200-degree field of view — 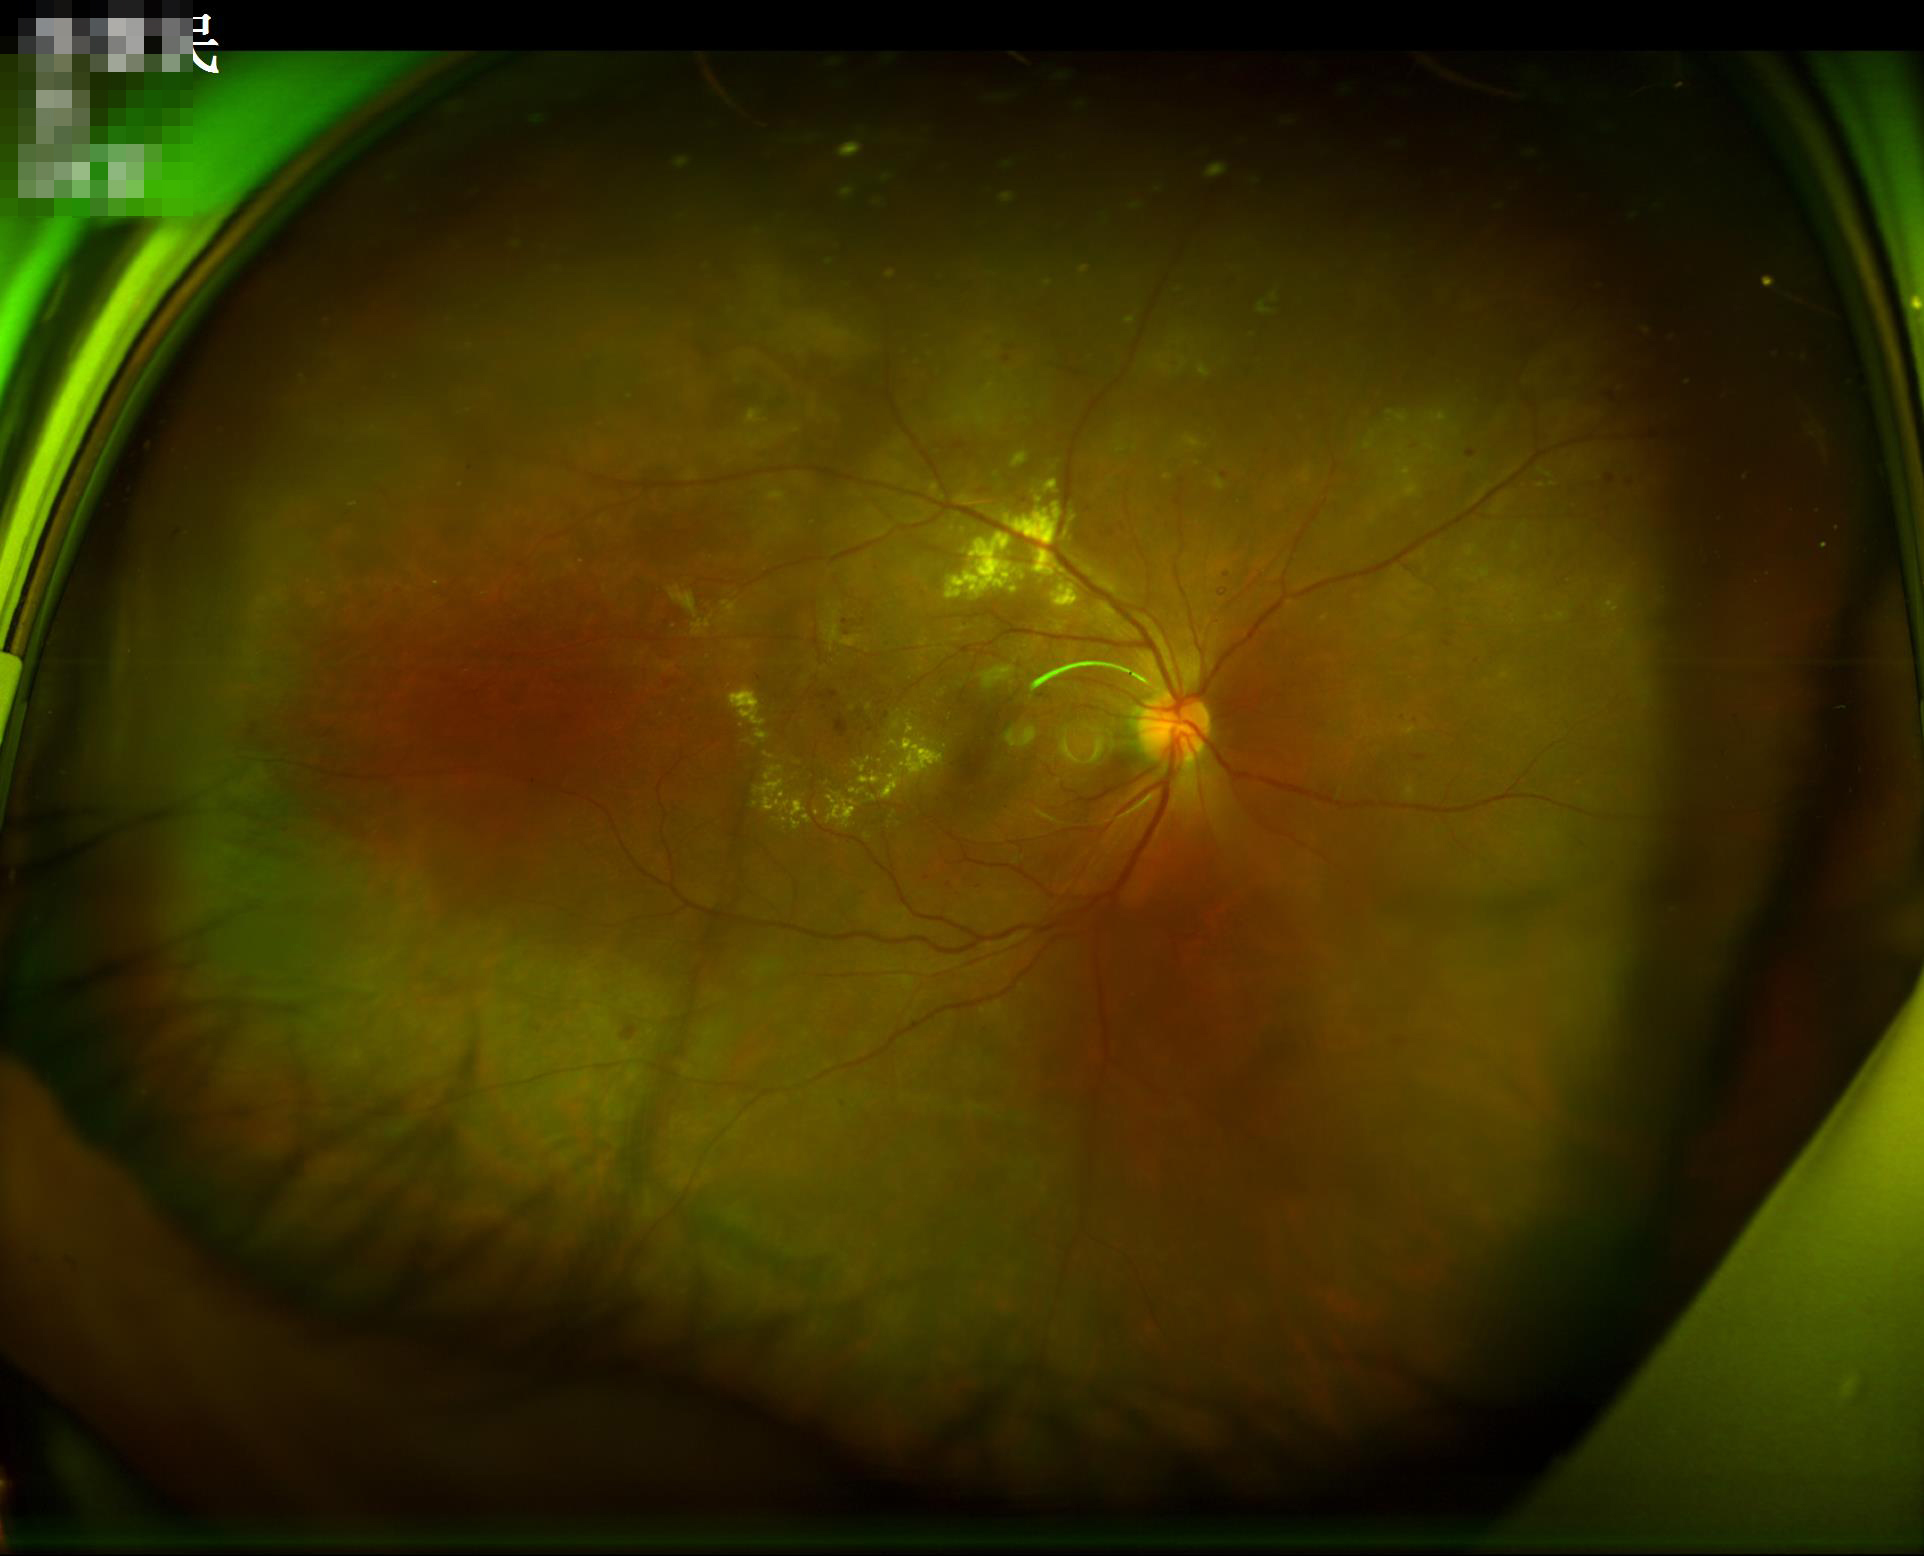

Image quality is adequate for diagnostic use. No over- or under-exposure. Vessels and details are readily distinguishable. Reduced sharpness with visible blur.